1240x1240 · Phoenix ICON wide-field infant fundus image.
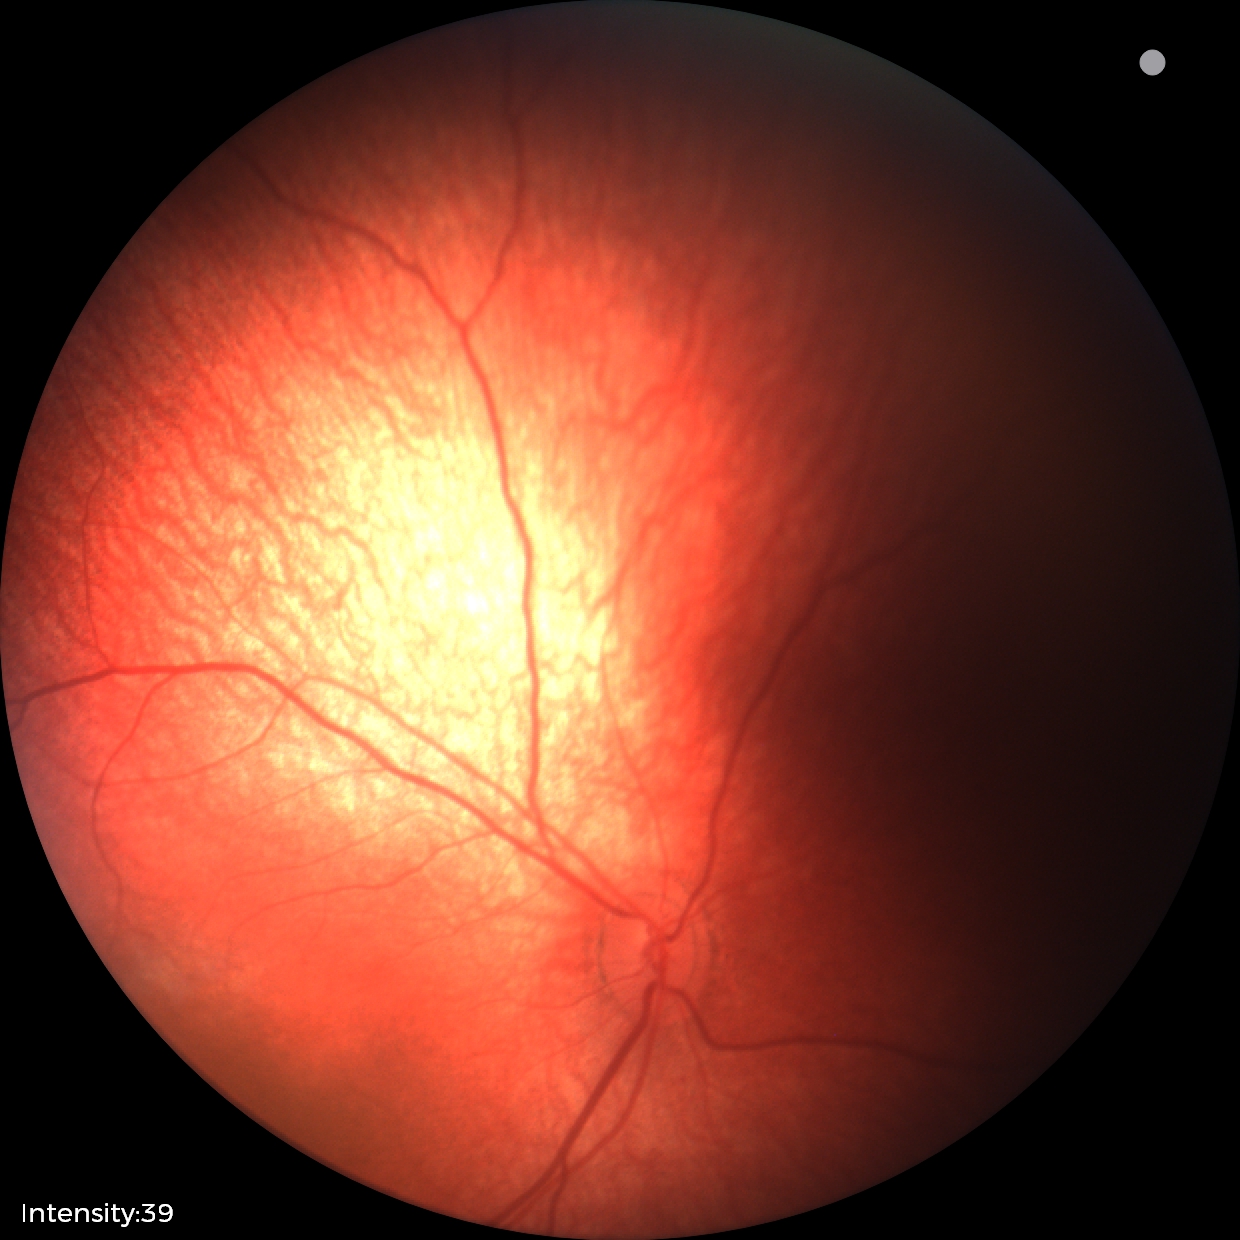
Physiological retinal appearance for postconceptual age.